Retinal fundus photograph · 45-degree field of view: 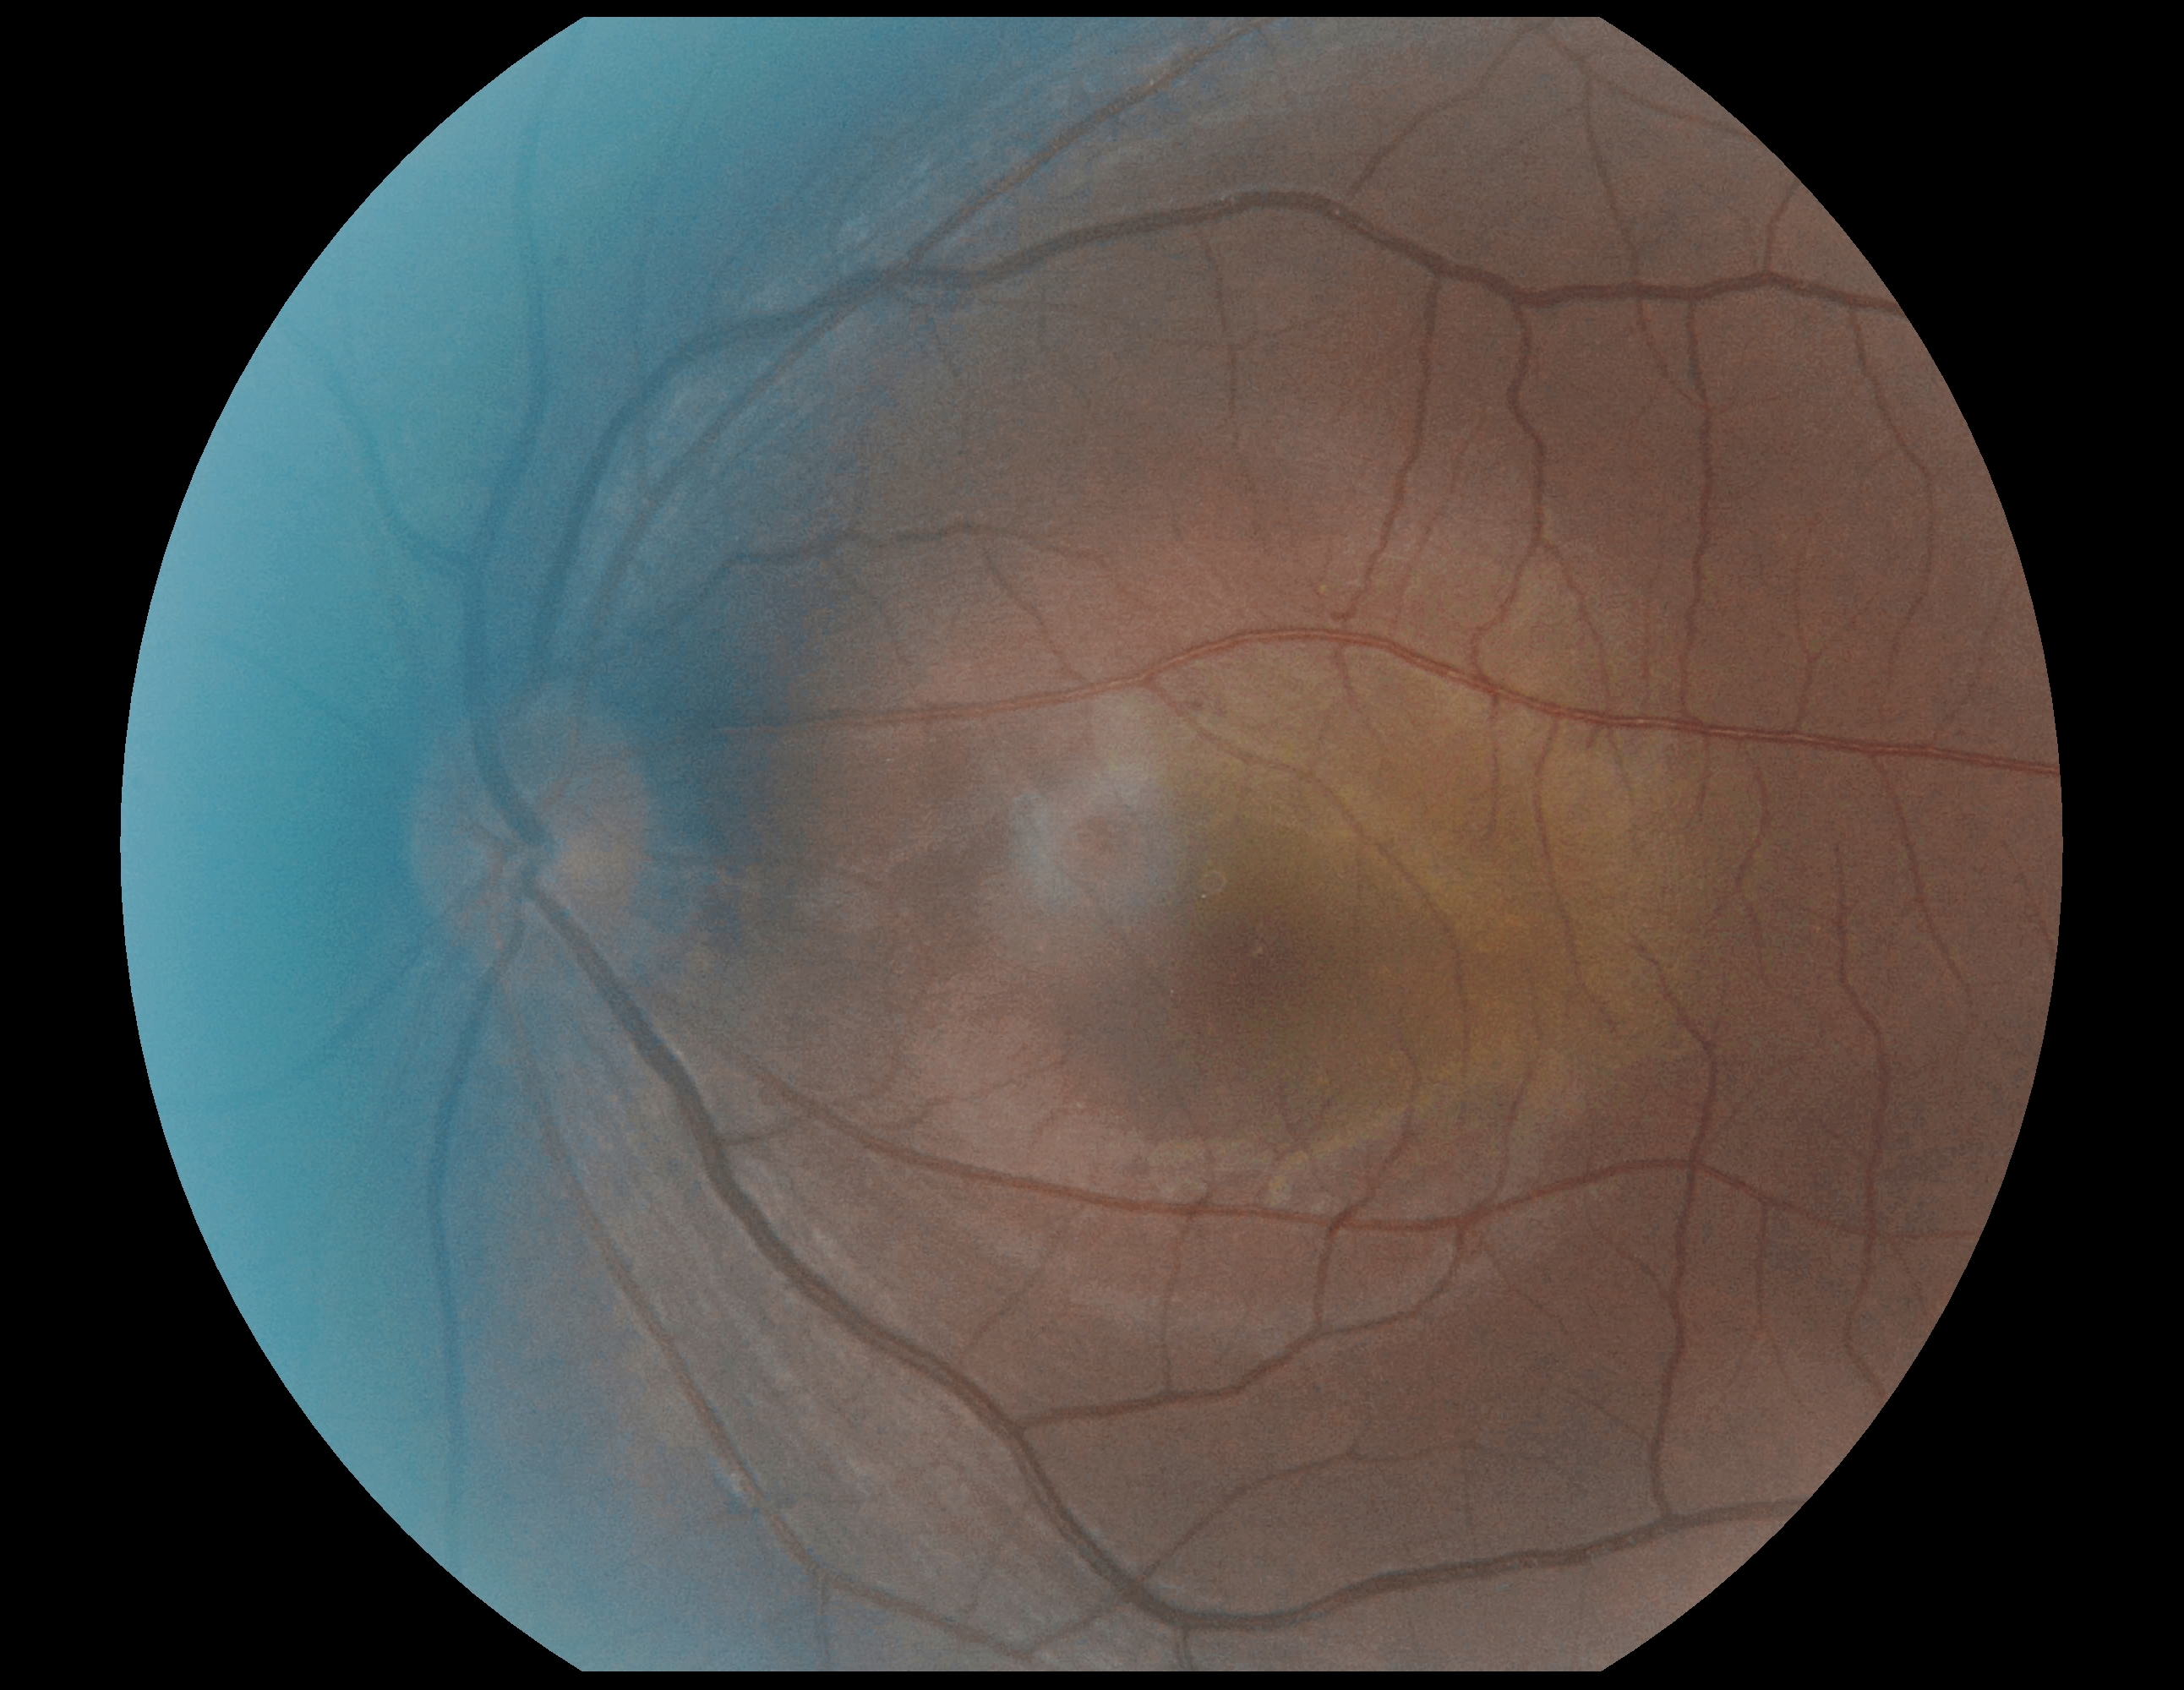
No DR findings.
Retinopathy: no apparent retinopathy (grade 0).